45 degree fundus photograph · camera: NIDEK AFC-230 · without pupil dilation:
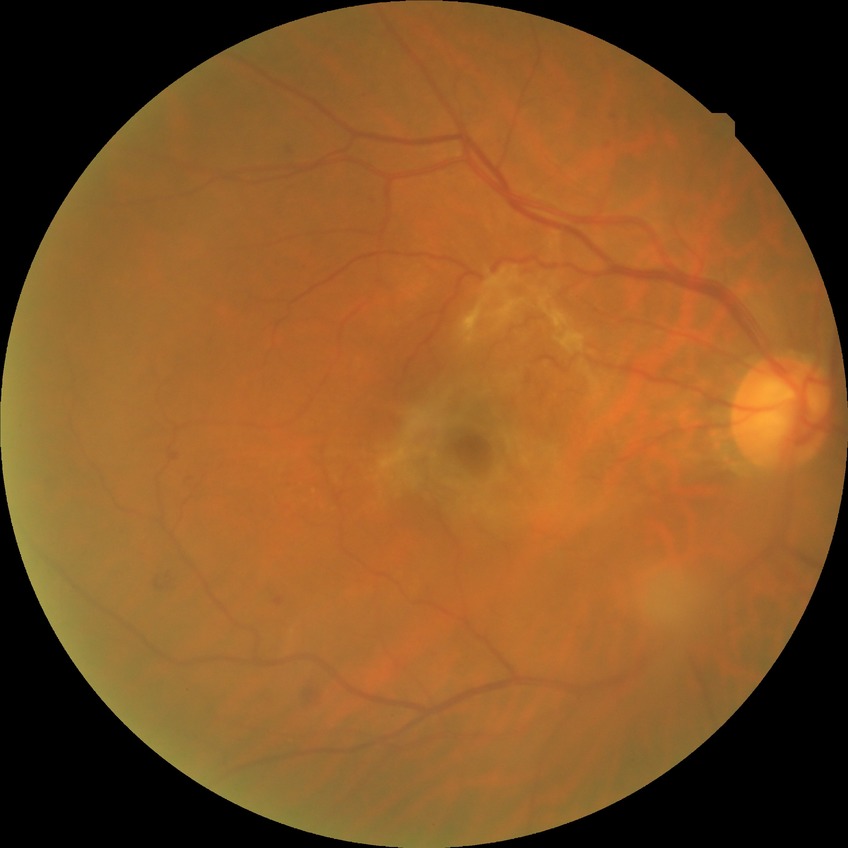

Diabetic retinopathy (DR): SDR (simple diabetic retinopathy).